Fundus photo · 45° field of view · 2048 by 1536 pixels:
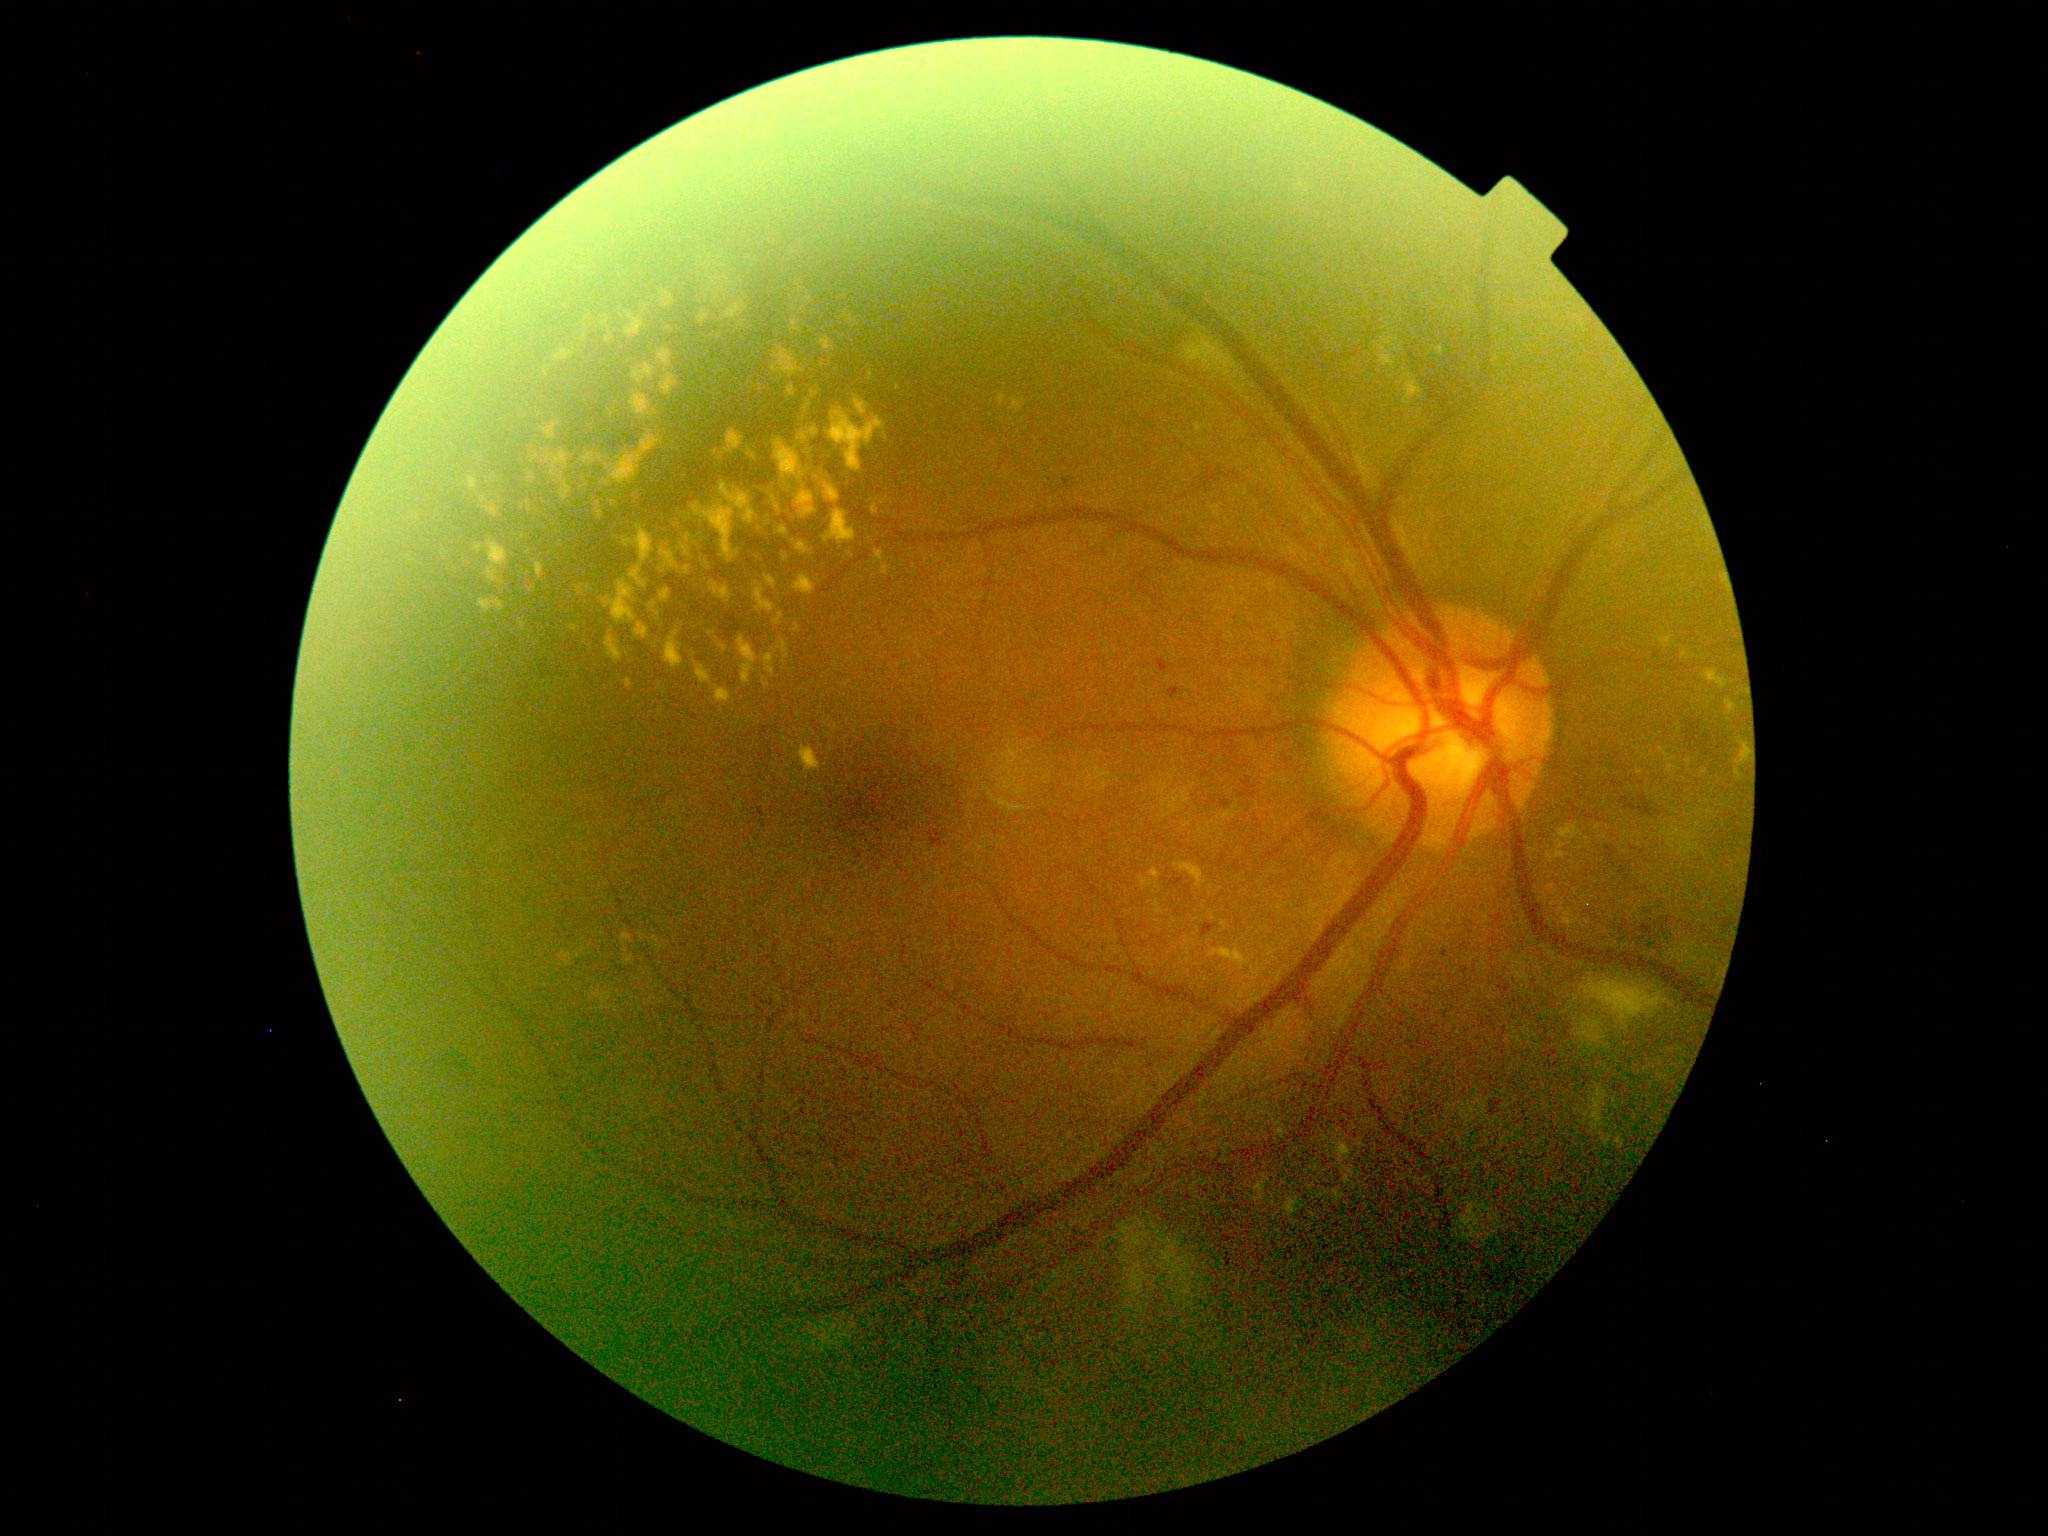

DR class: non-proliferative diabetic retinopathy; diabetic retinopathy (DR): grade 2 (moderate NPDR).